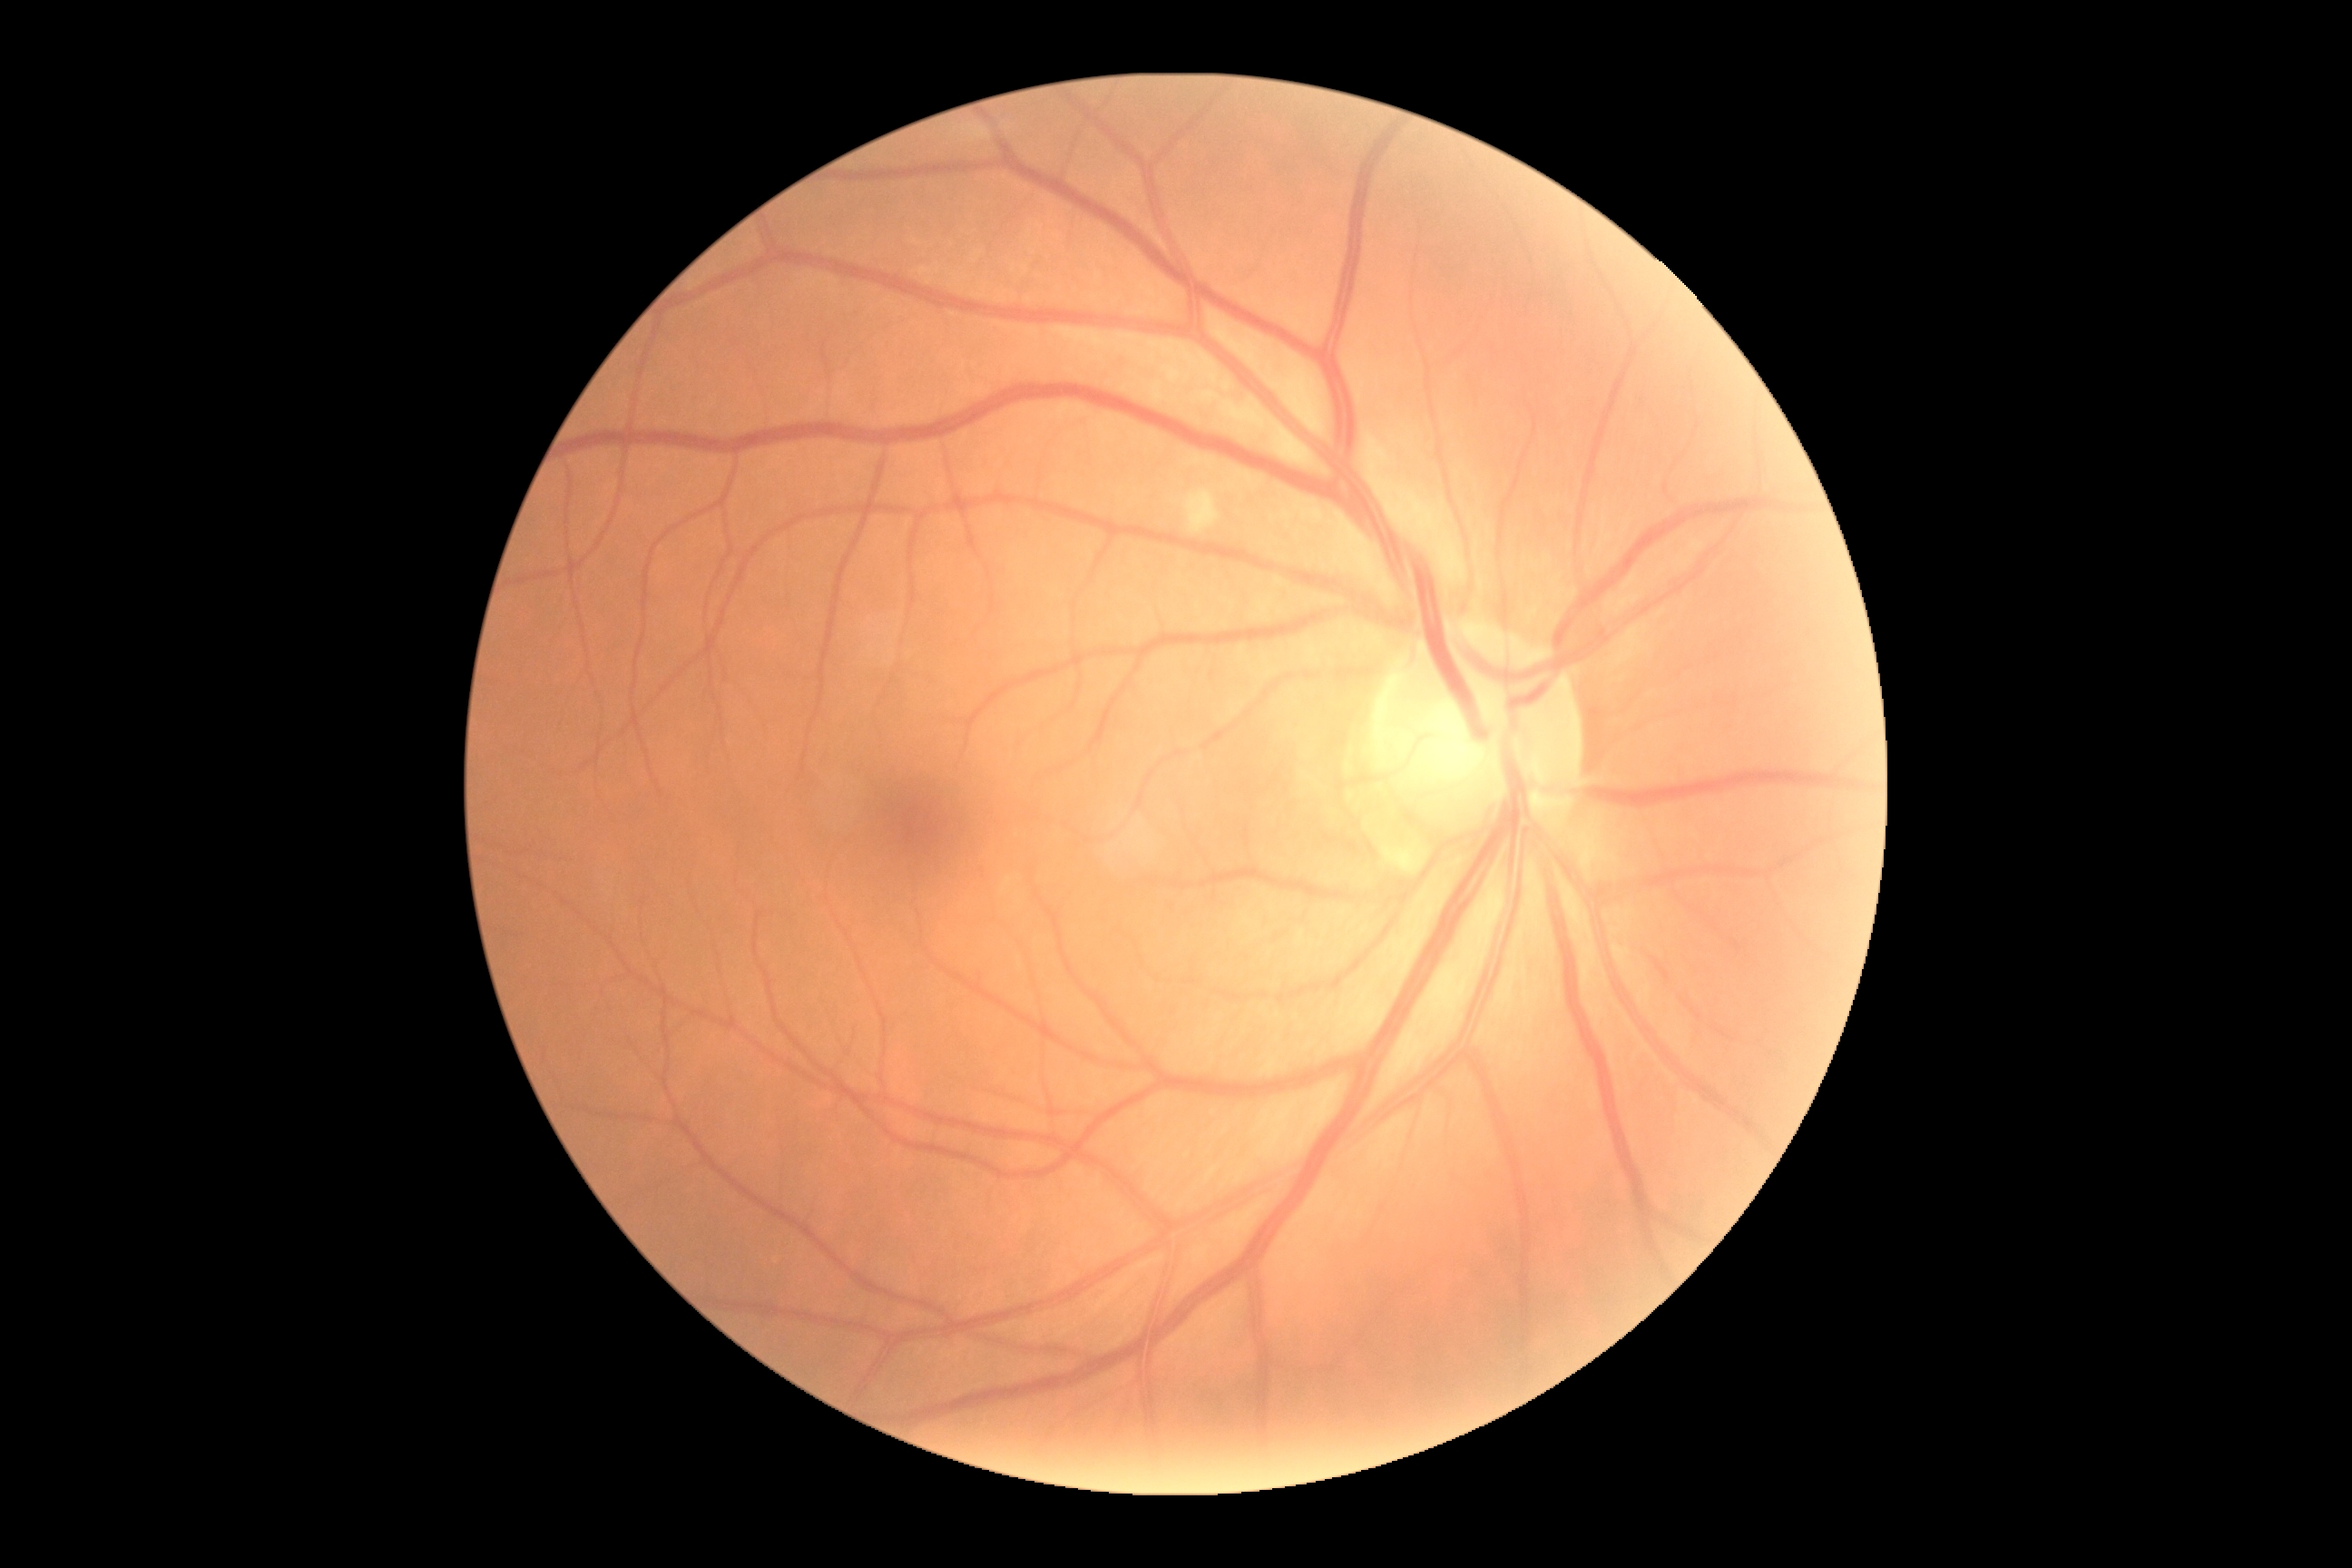

Diabetic retinopathy (DR): 2/4.